Retinal fundus photograph:
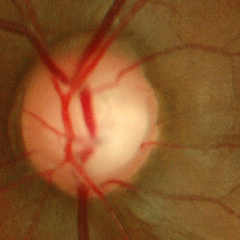

Glaucoma is present. Showing early glaucoma.